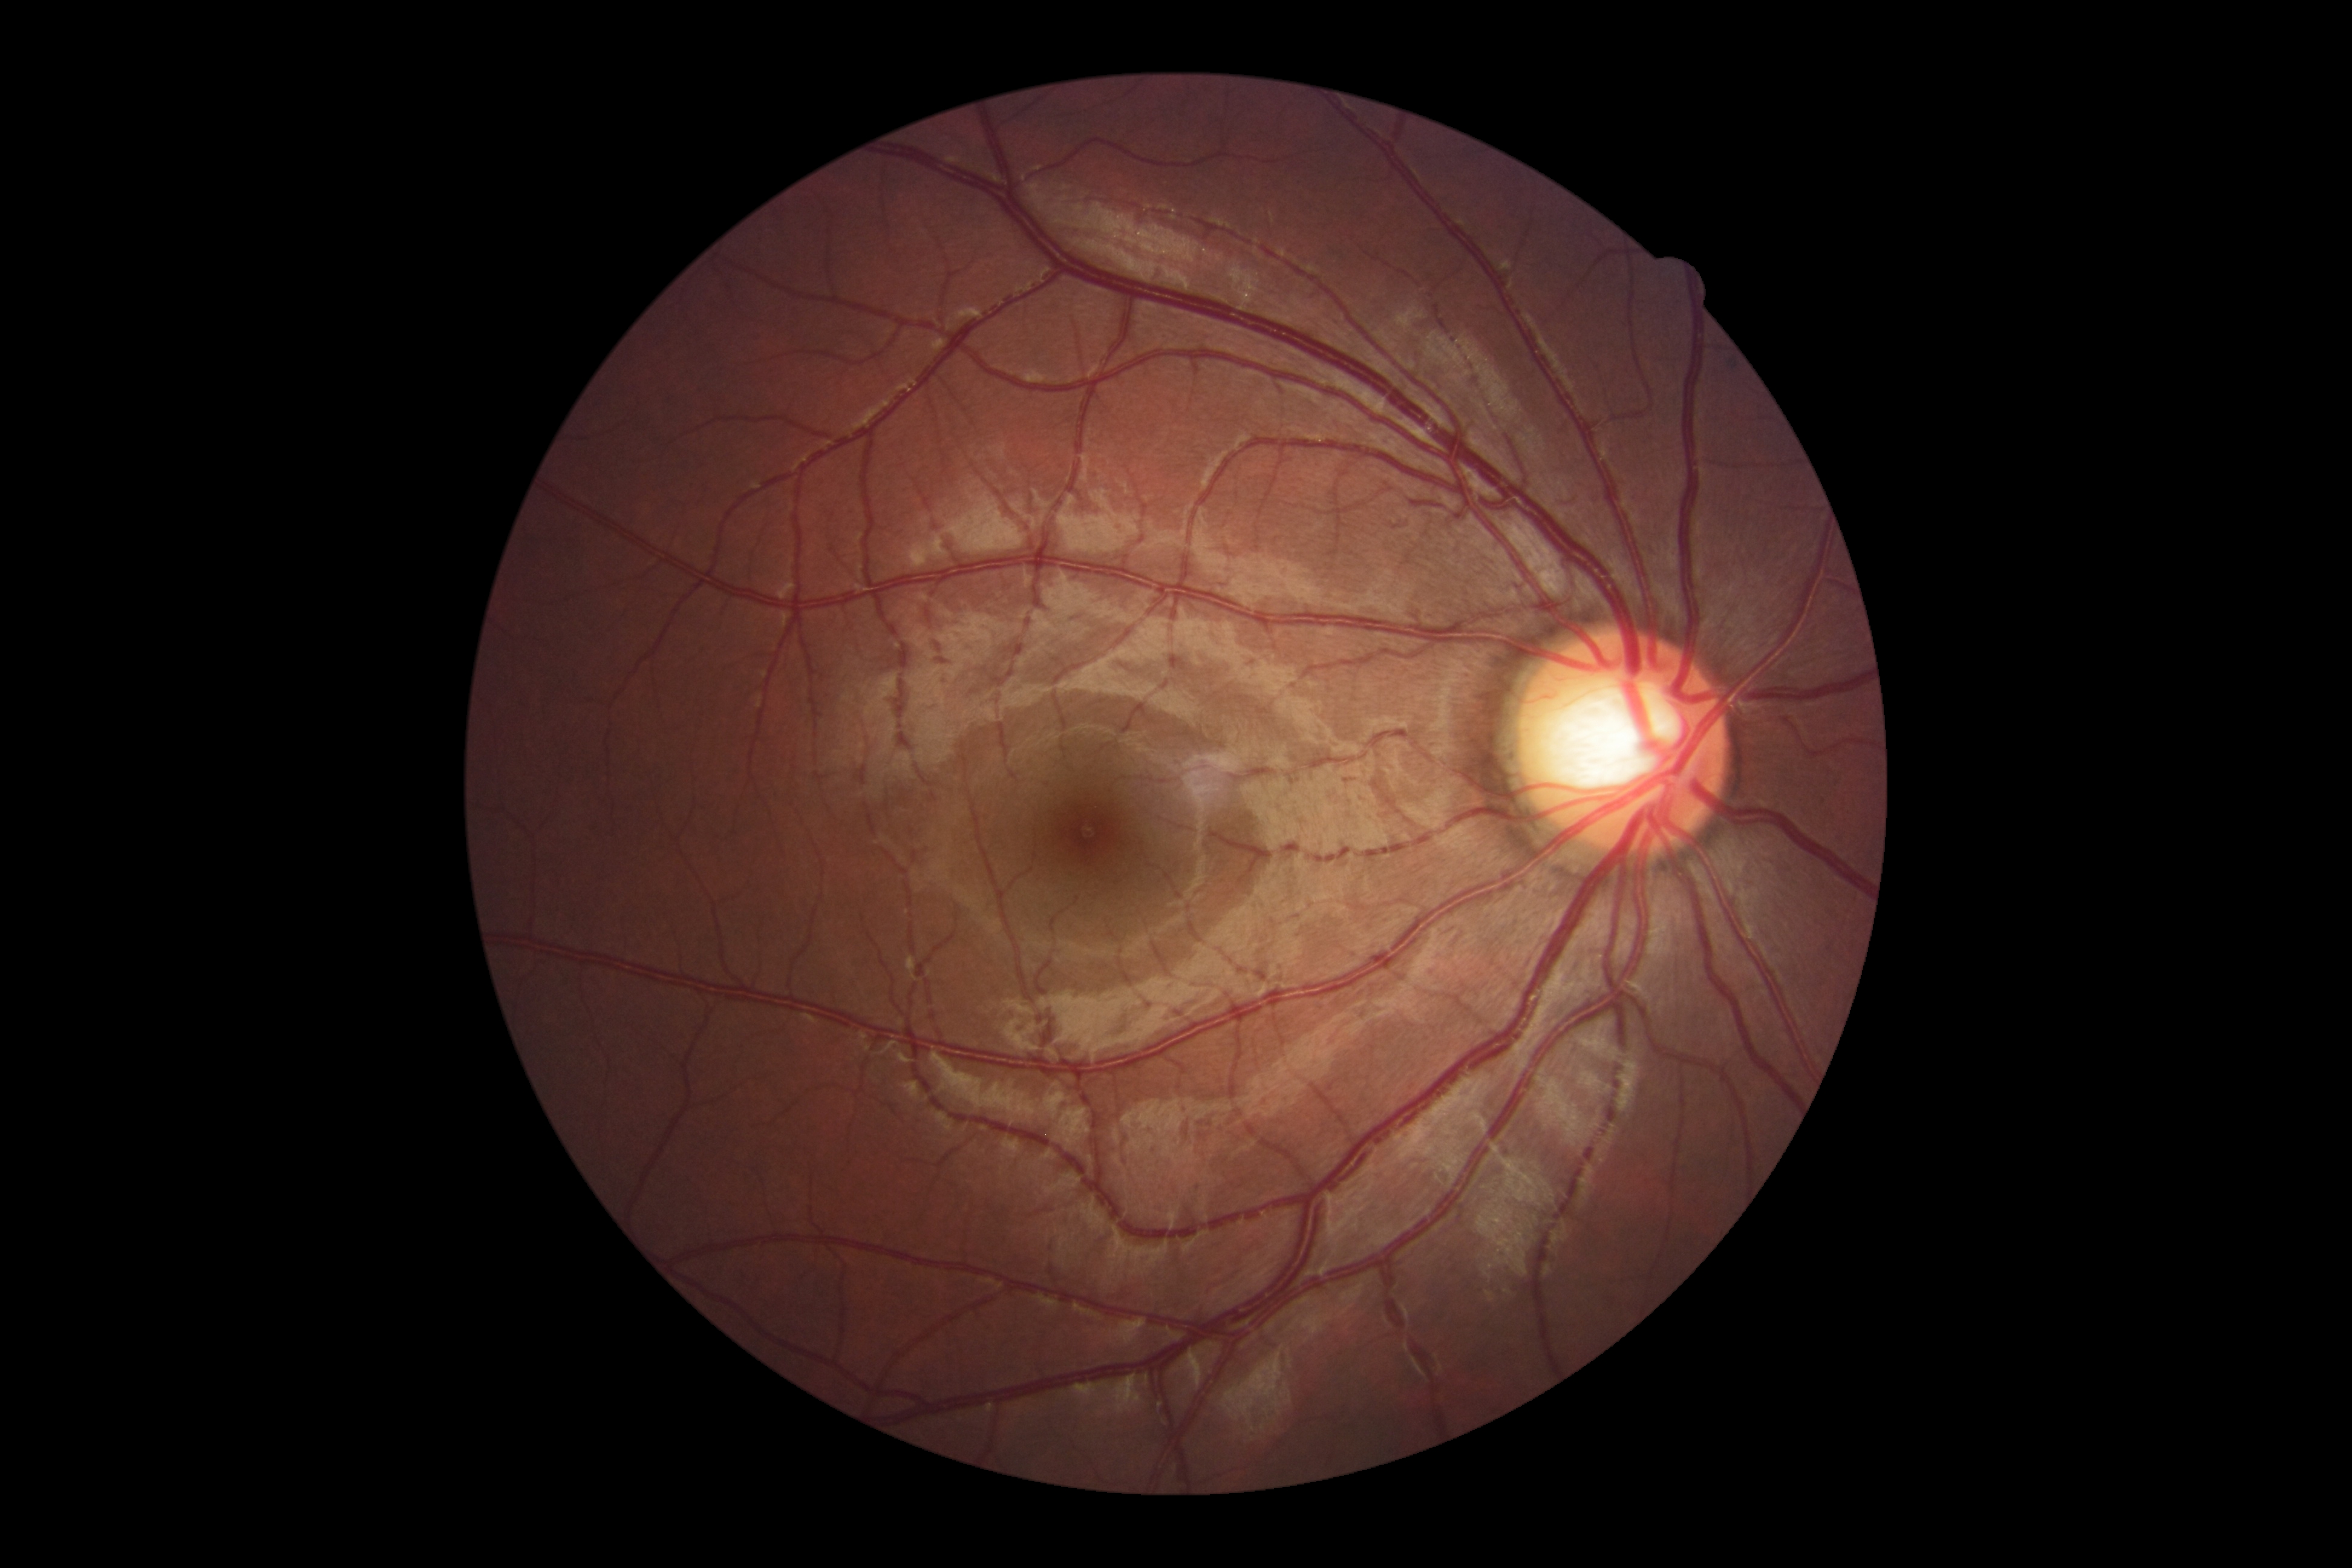
DR: grade 0 (no apparent retinopathy).
No signs of diabetic retinopathy.